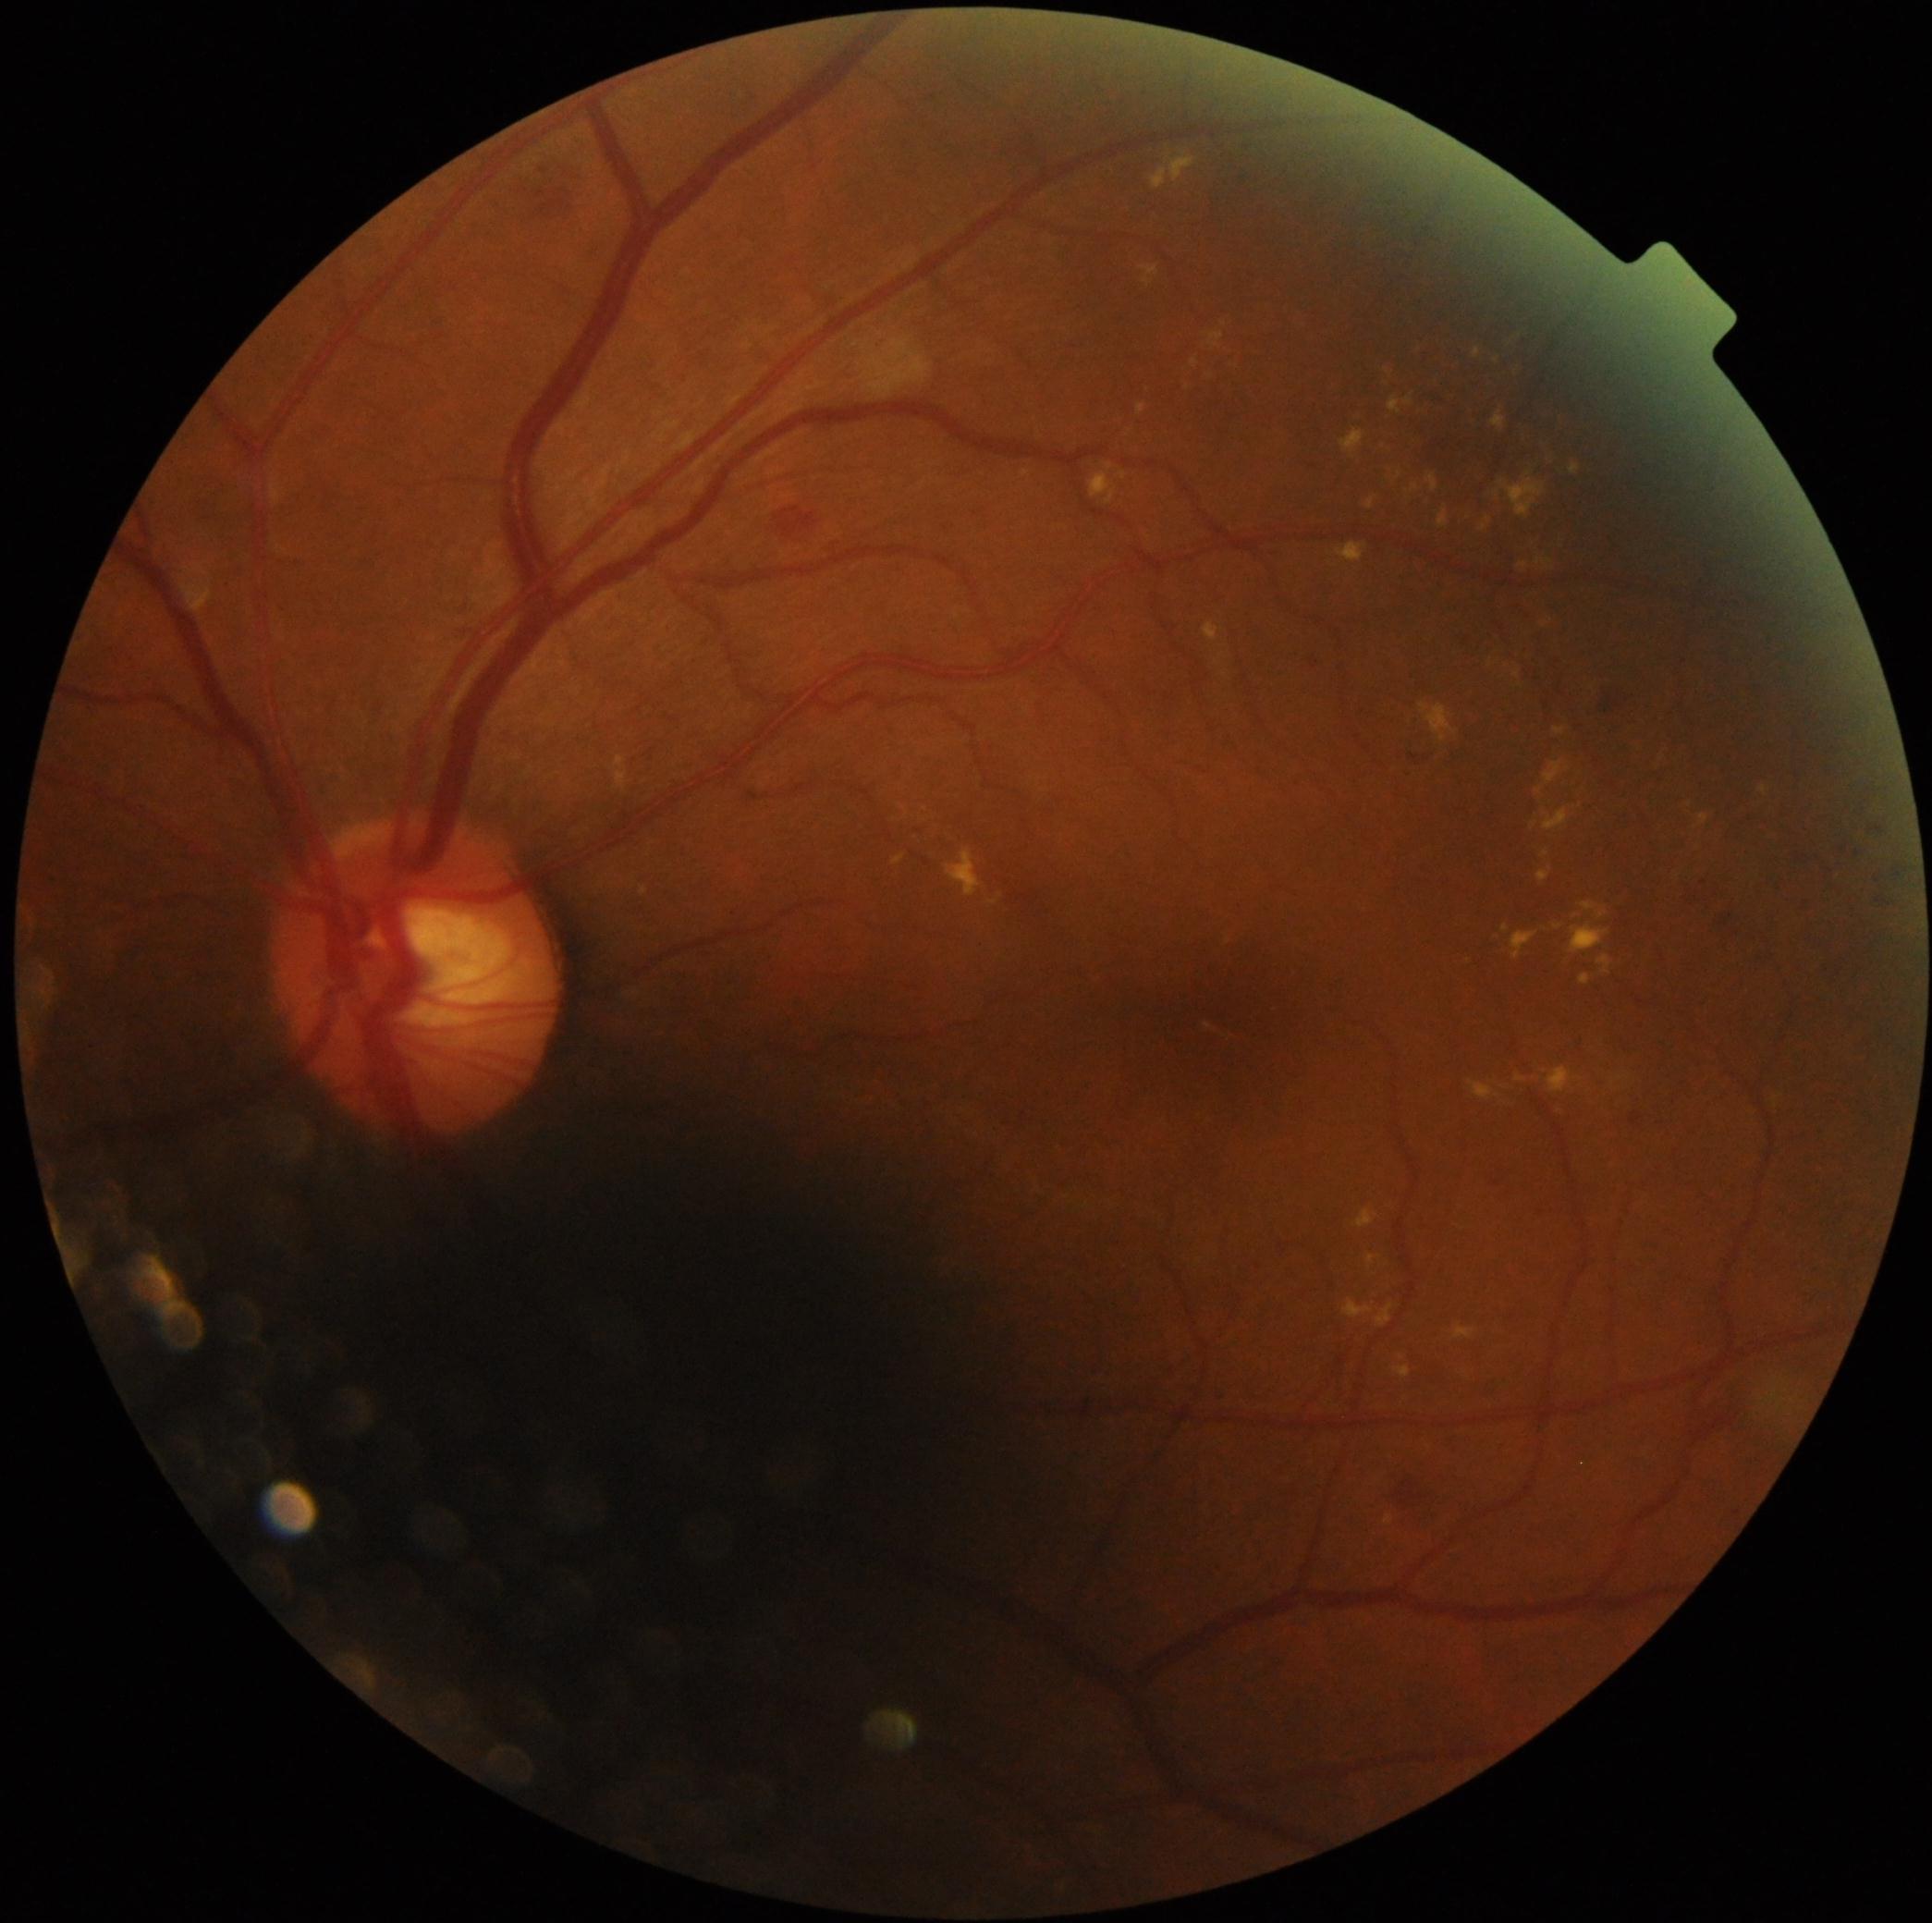
{
  "dr_grade": "moderate NPDR (grade 2)"
}